Fundus photo: 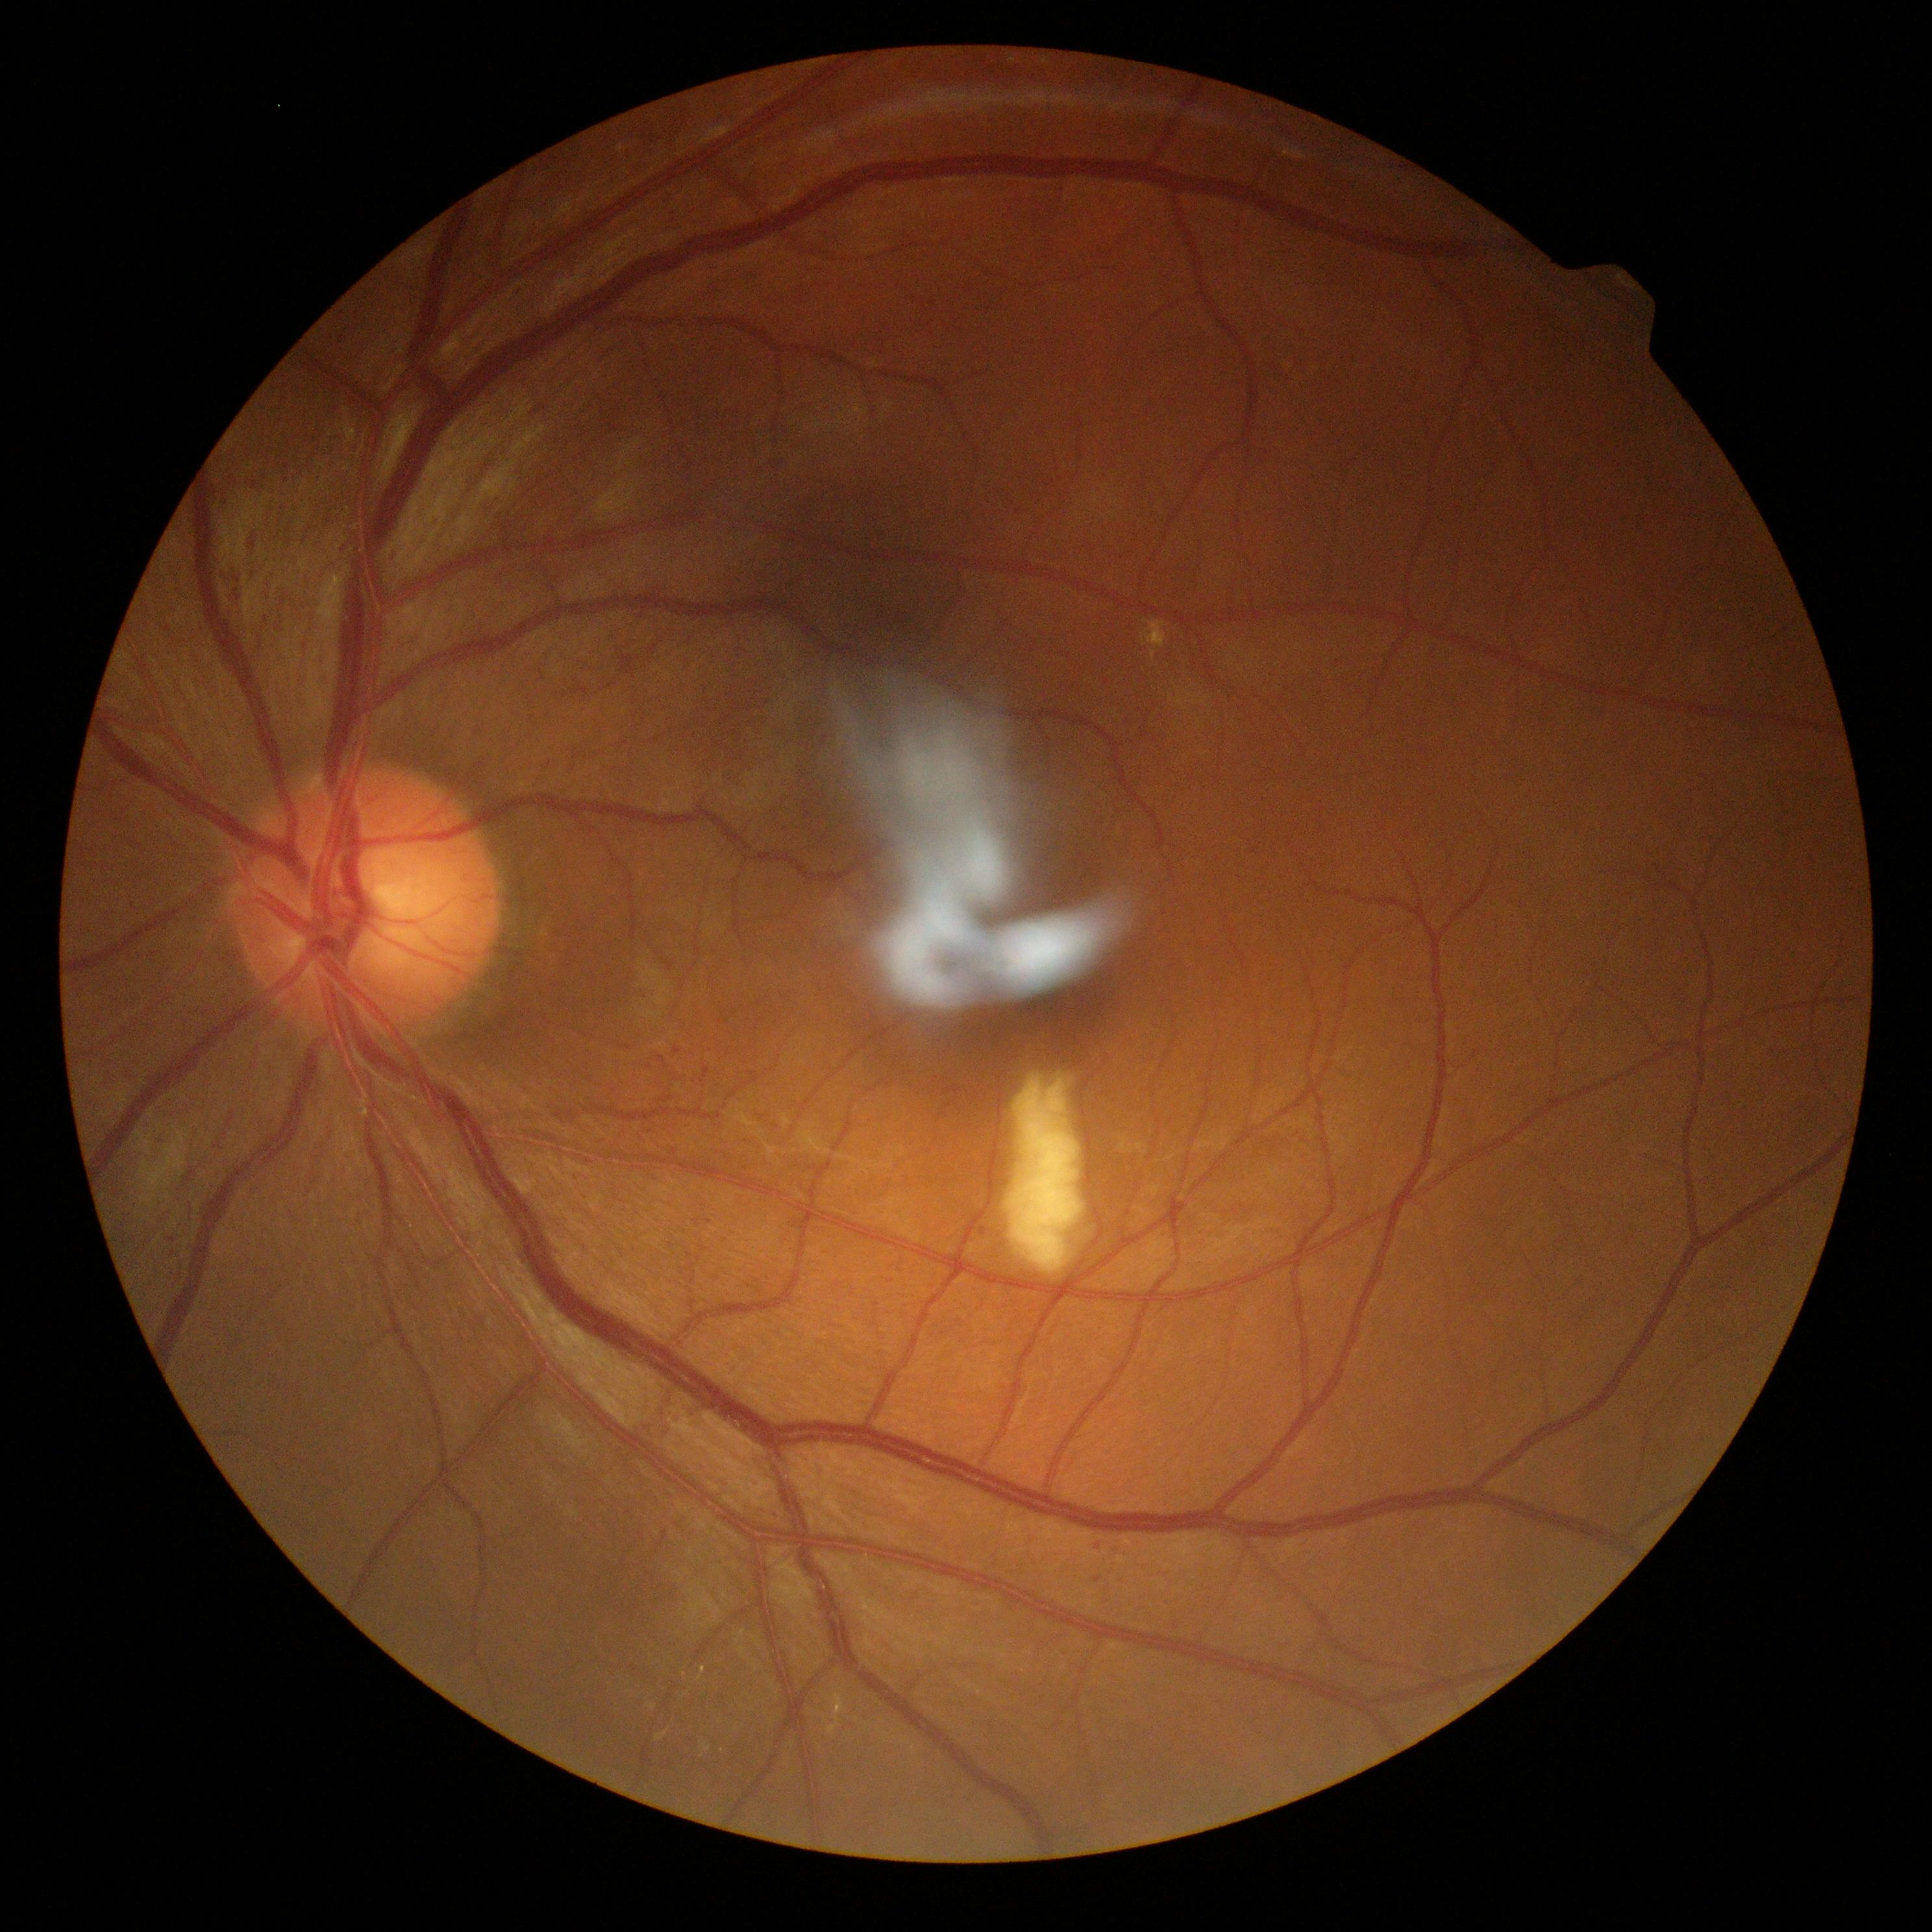 {"dr_grade": "2"}